Color fundus image — 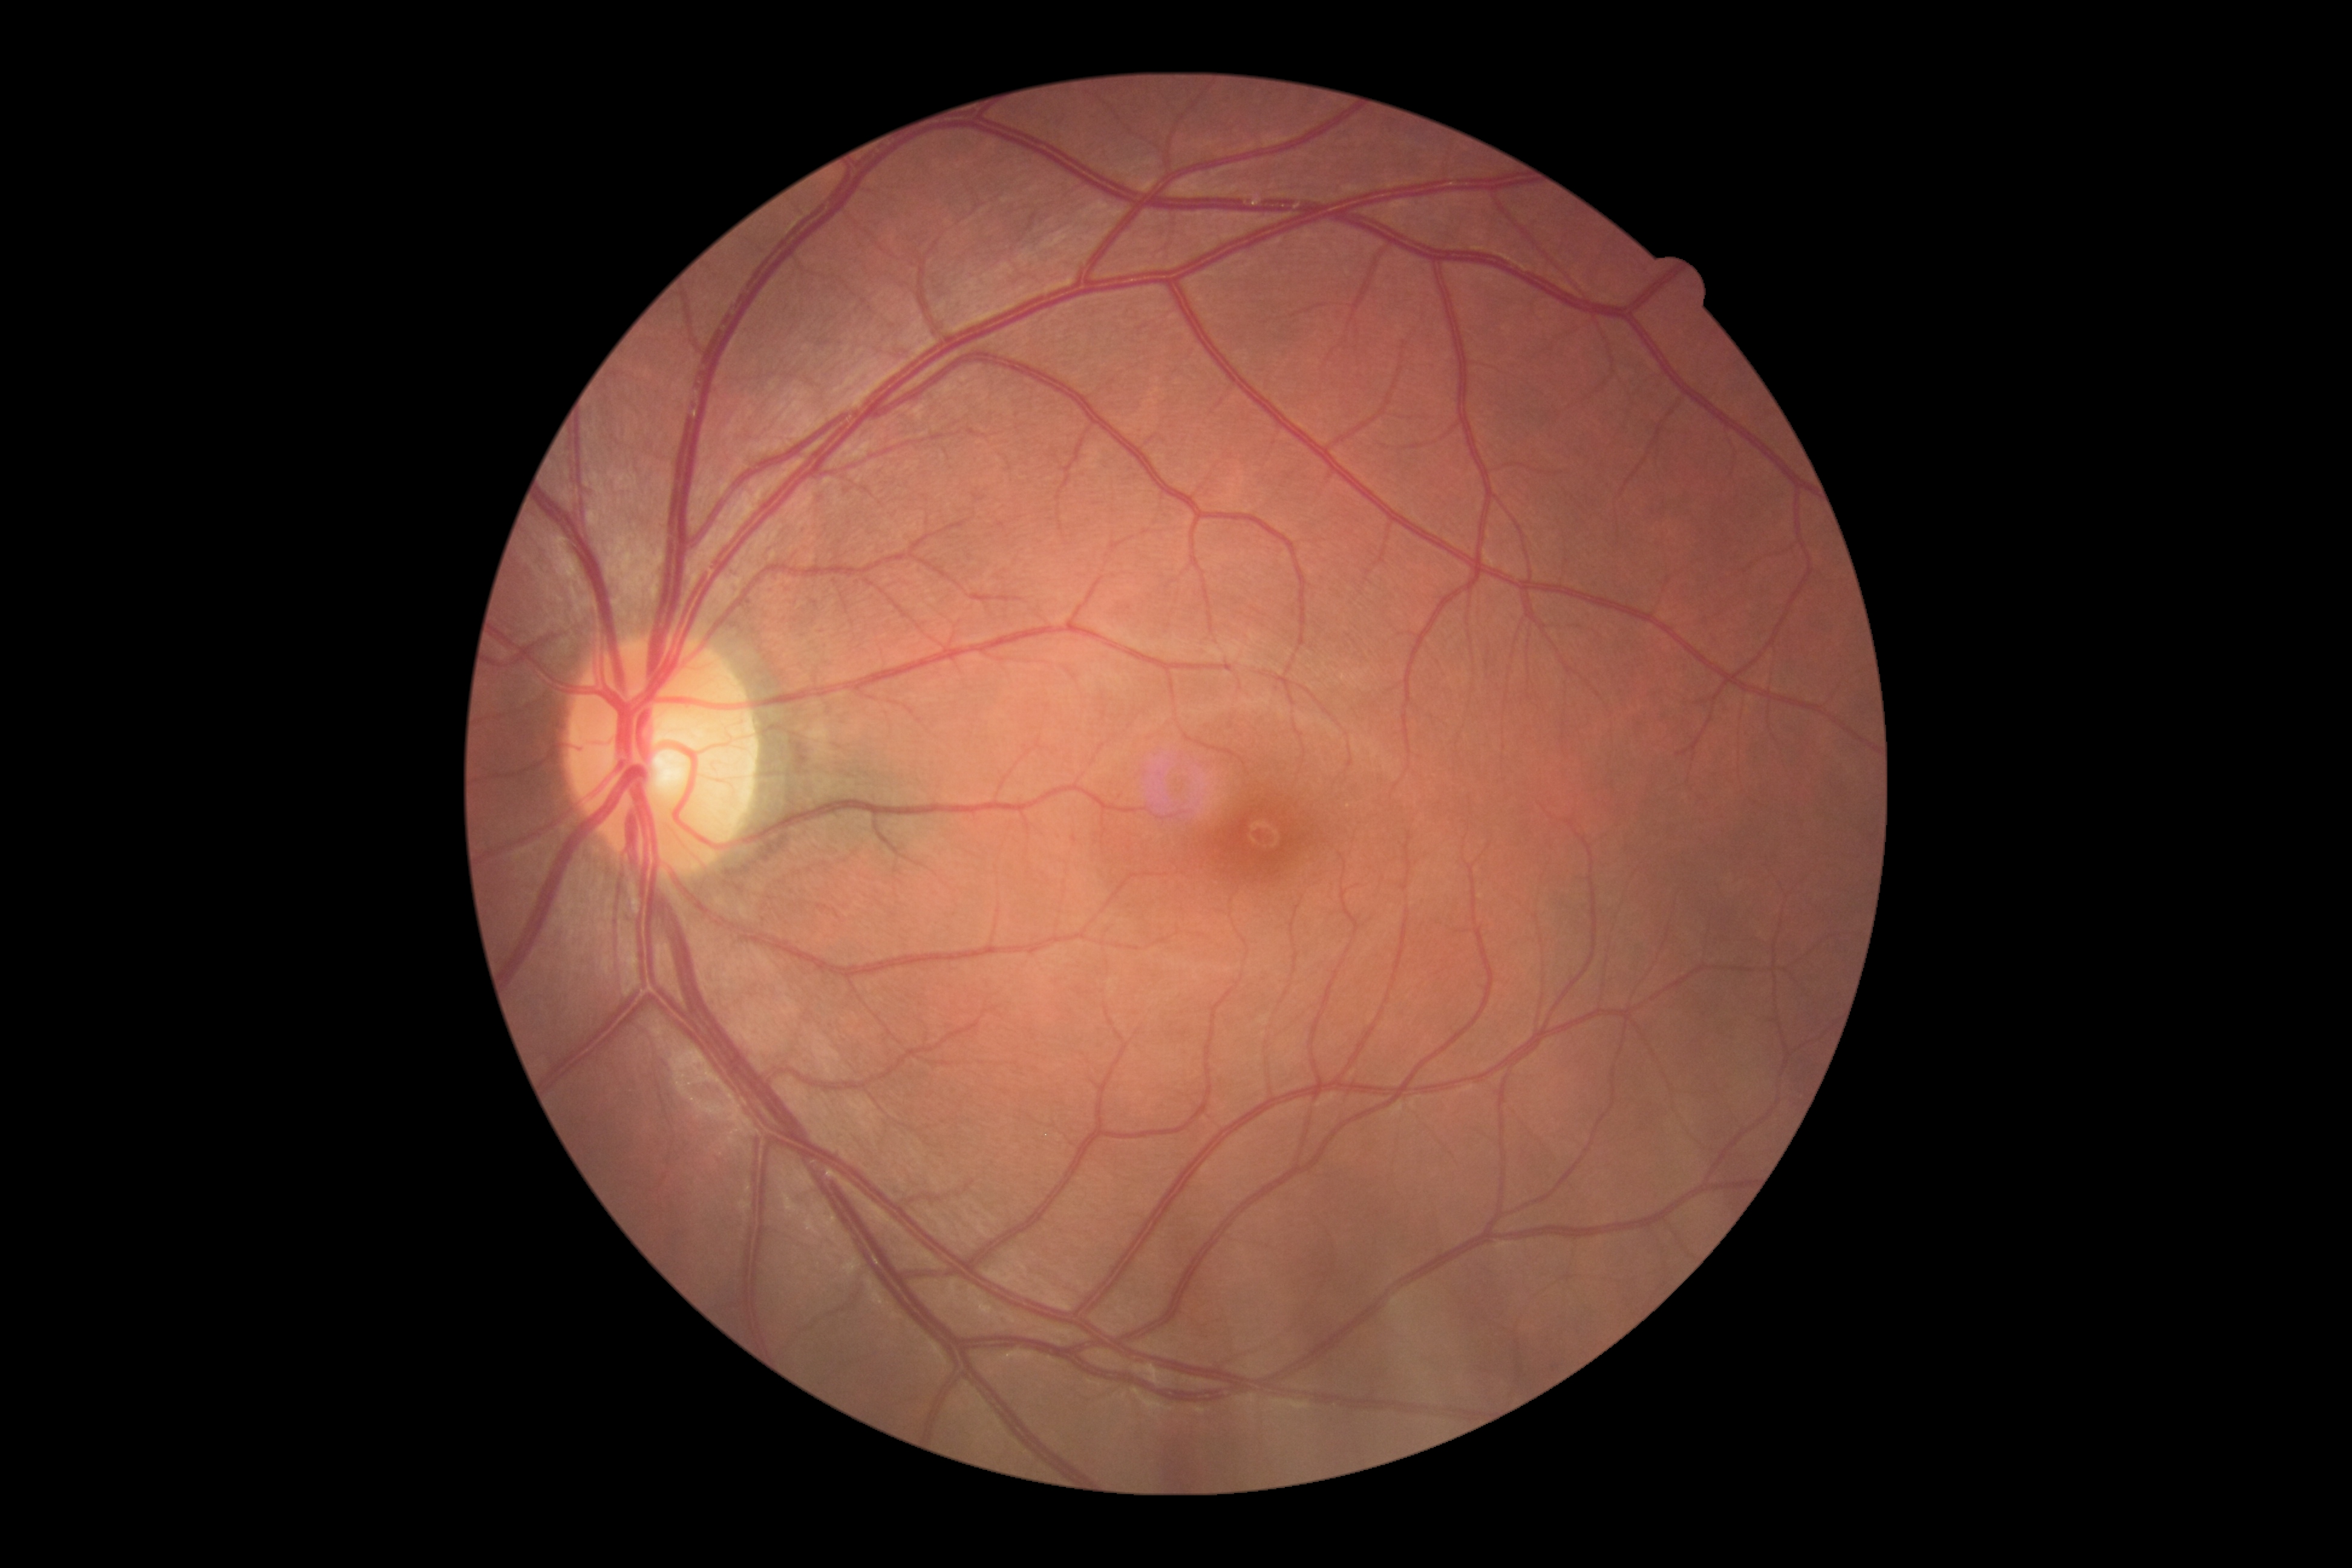

diabetic retinopathy severity = no apparent diabetic retinopathy (grade 0)